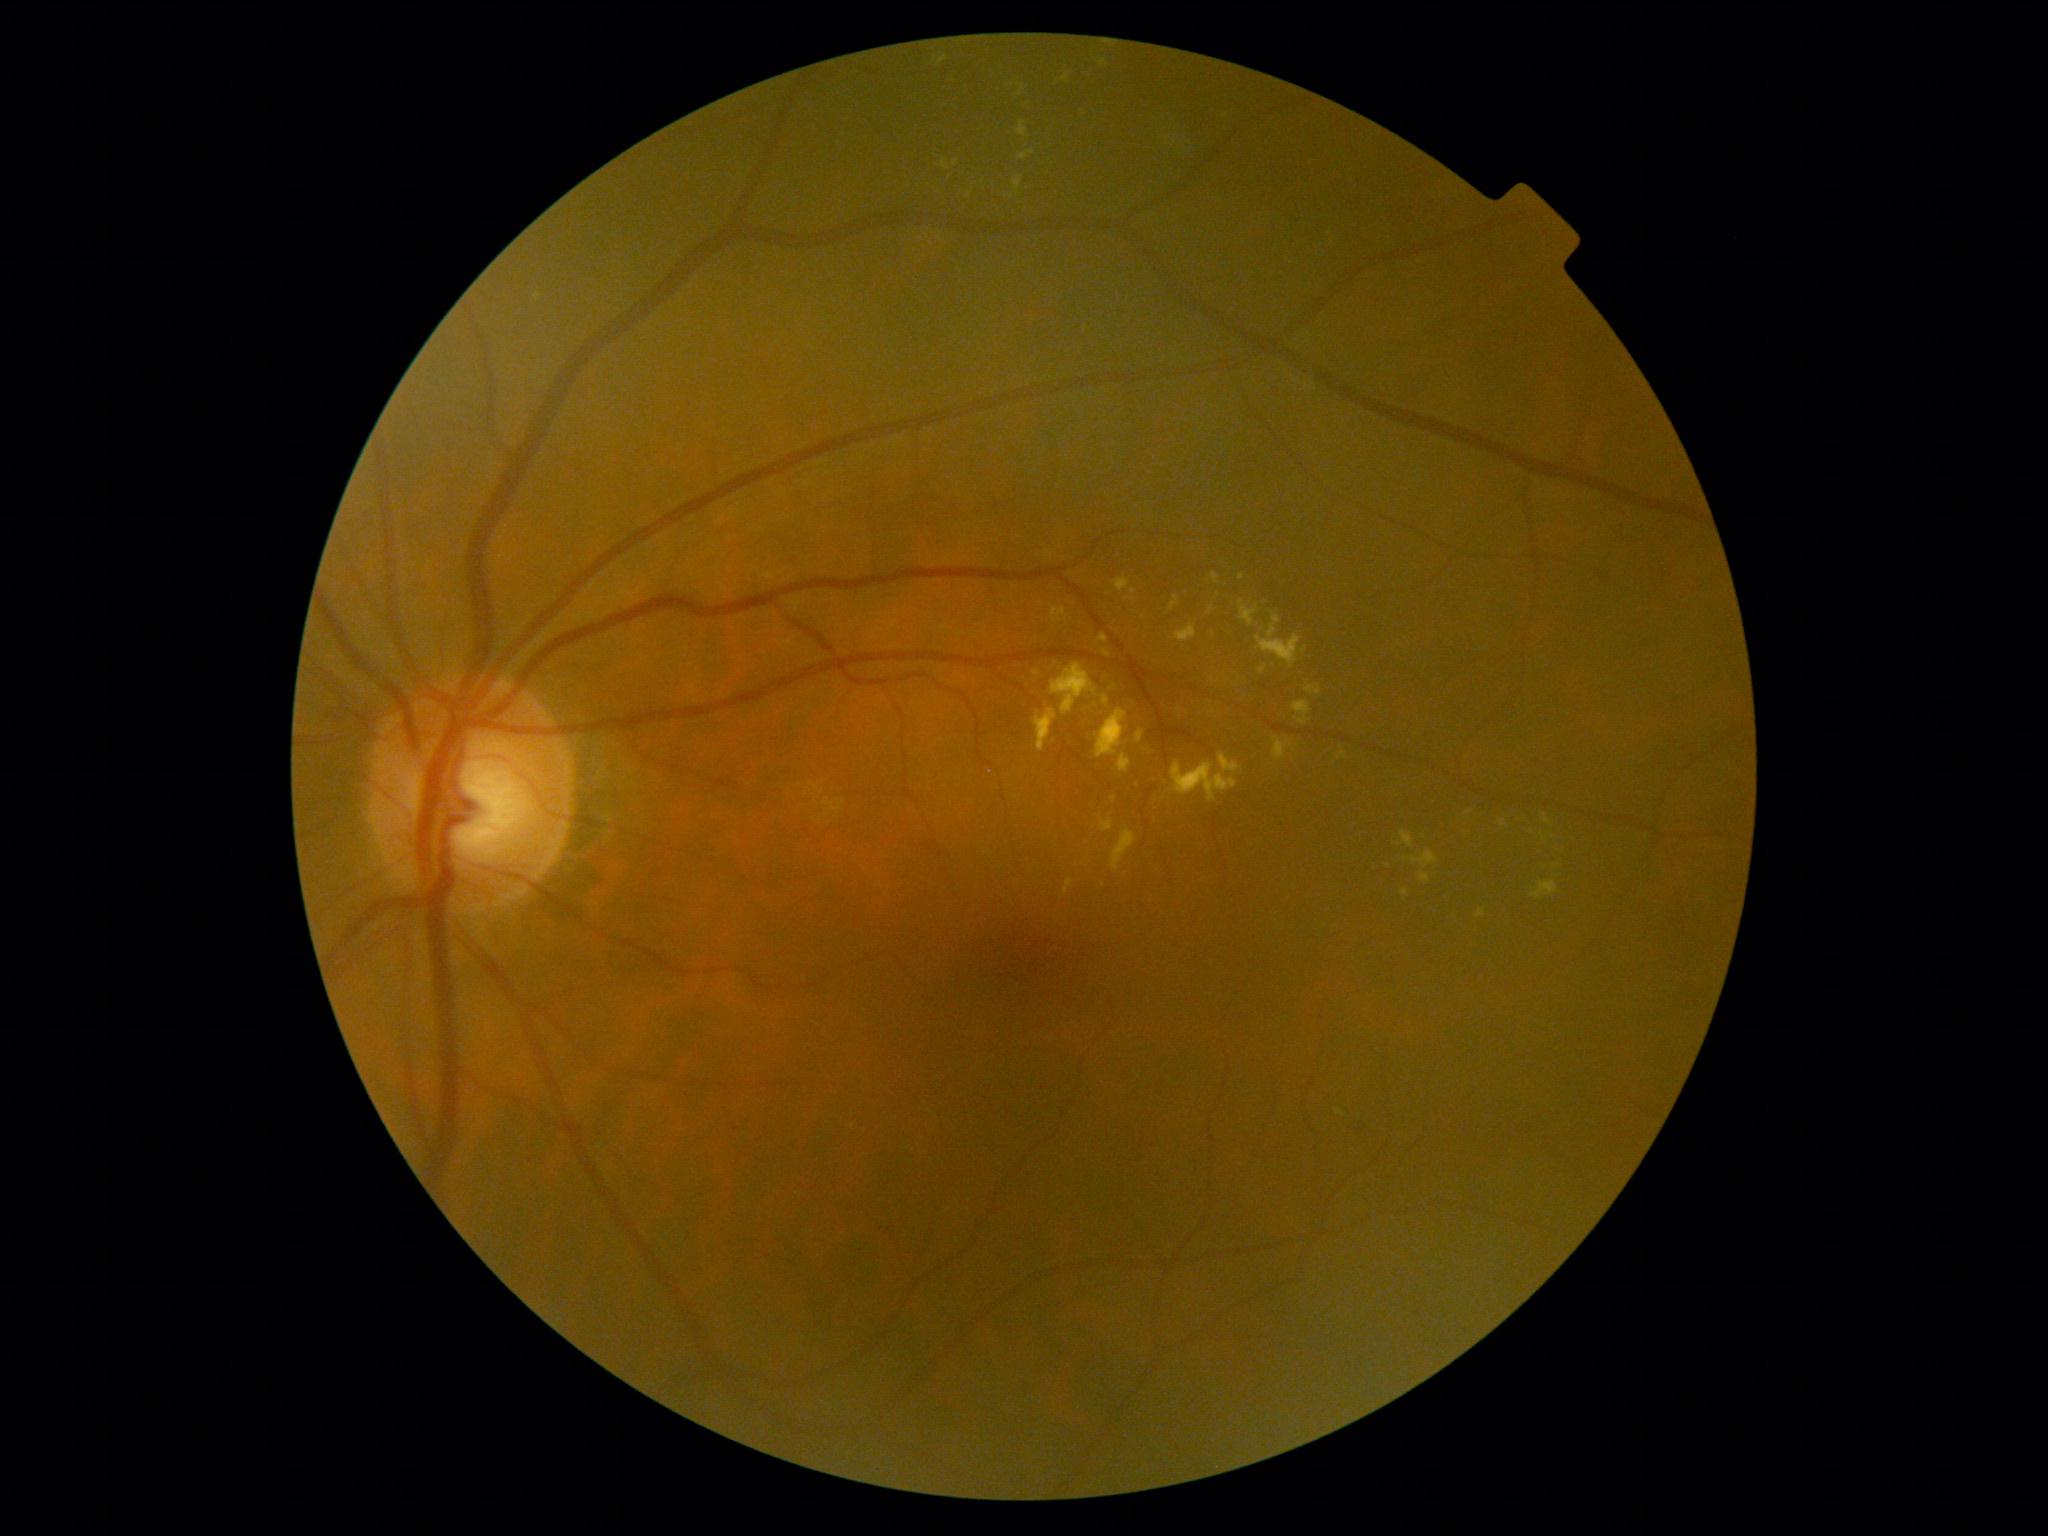
Diabetic retinopathy grade: 2 — more than just microaneurysms but less than severe NPDR
Representative lesions:
soft exudates: none
hemorrhages: none
hard exudates (more not shown): box(1112, 829, 1137, 872), box(1274, 737, 1291, 760), box(1170, 597, 1179, 611), box(1103, 696, 1110, 707), box(1401, 831, 1414, 849), box(1406, 852, 1437, 868), box(1543, 816, 1552, 826), box(1401, 889, 1409, 897), box(938, 56, 948, 66), box(1018, 151, 1036, 161), box(1172, 762, 1238, 802)
Hard exudates (small, approximate centers) near pt(1424, 836), pt(1389, 866), pt(538, 297), pt(955, 163), pt(1134, 592)
microaneurysms: none